DR severity per modified Davis staging — 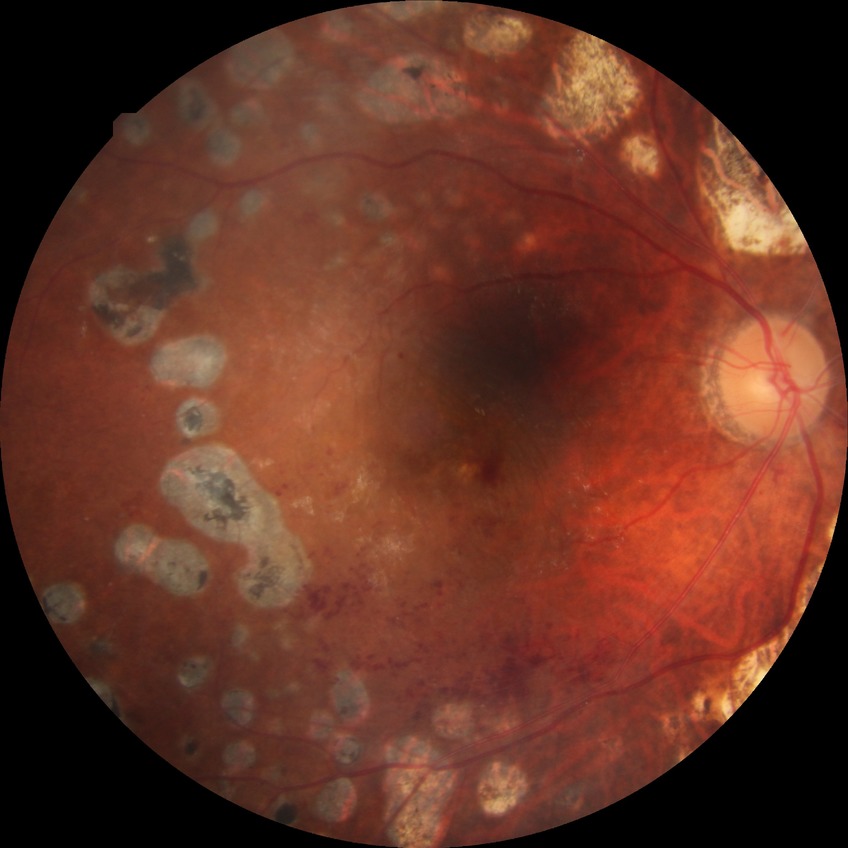
DR grade is PDR.